45-degree field of view · no pharmacologic dilation — 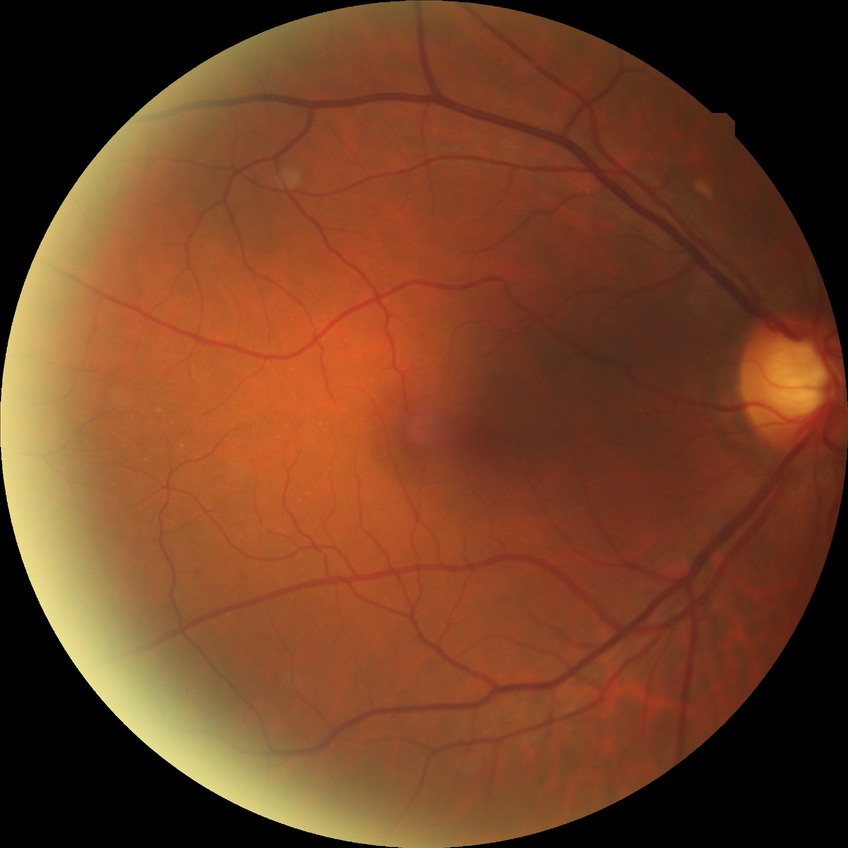

Assessment:
- diabetic retinopathy (DR): NDR (no diabetic retinopathy)